Mydriatic (tropicamide and phenylephrine).
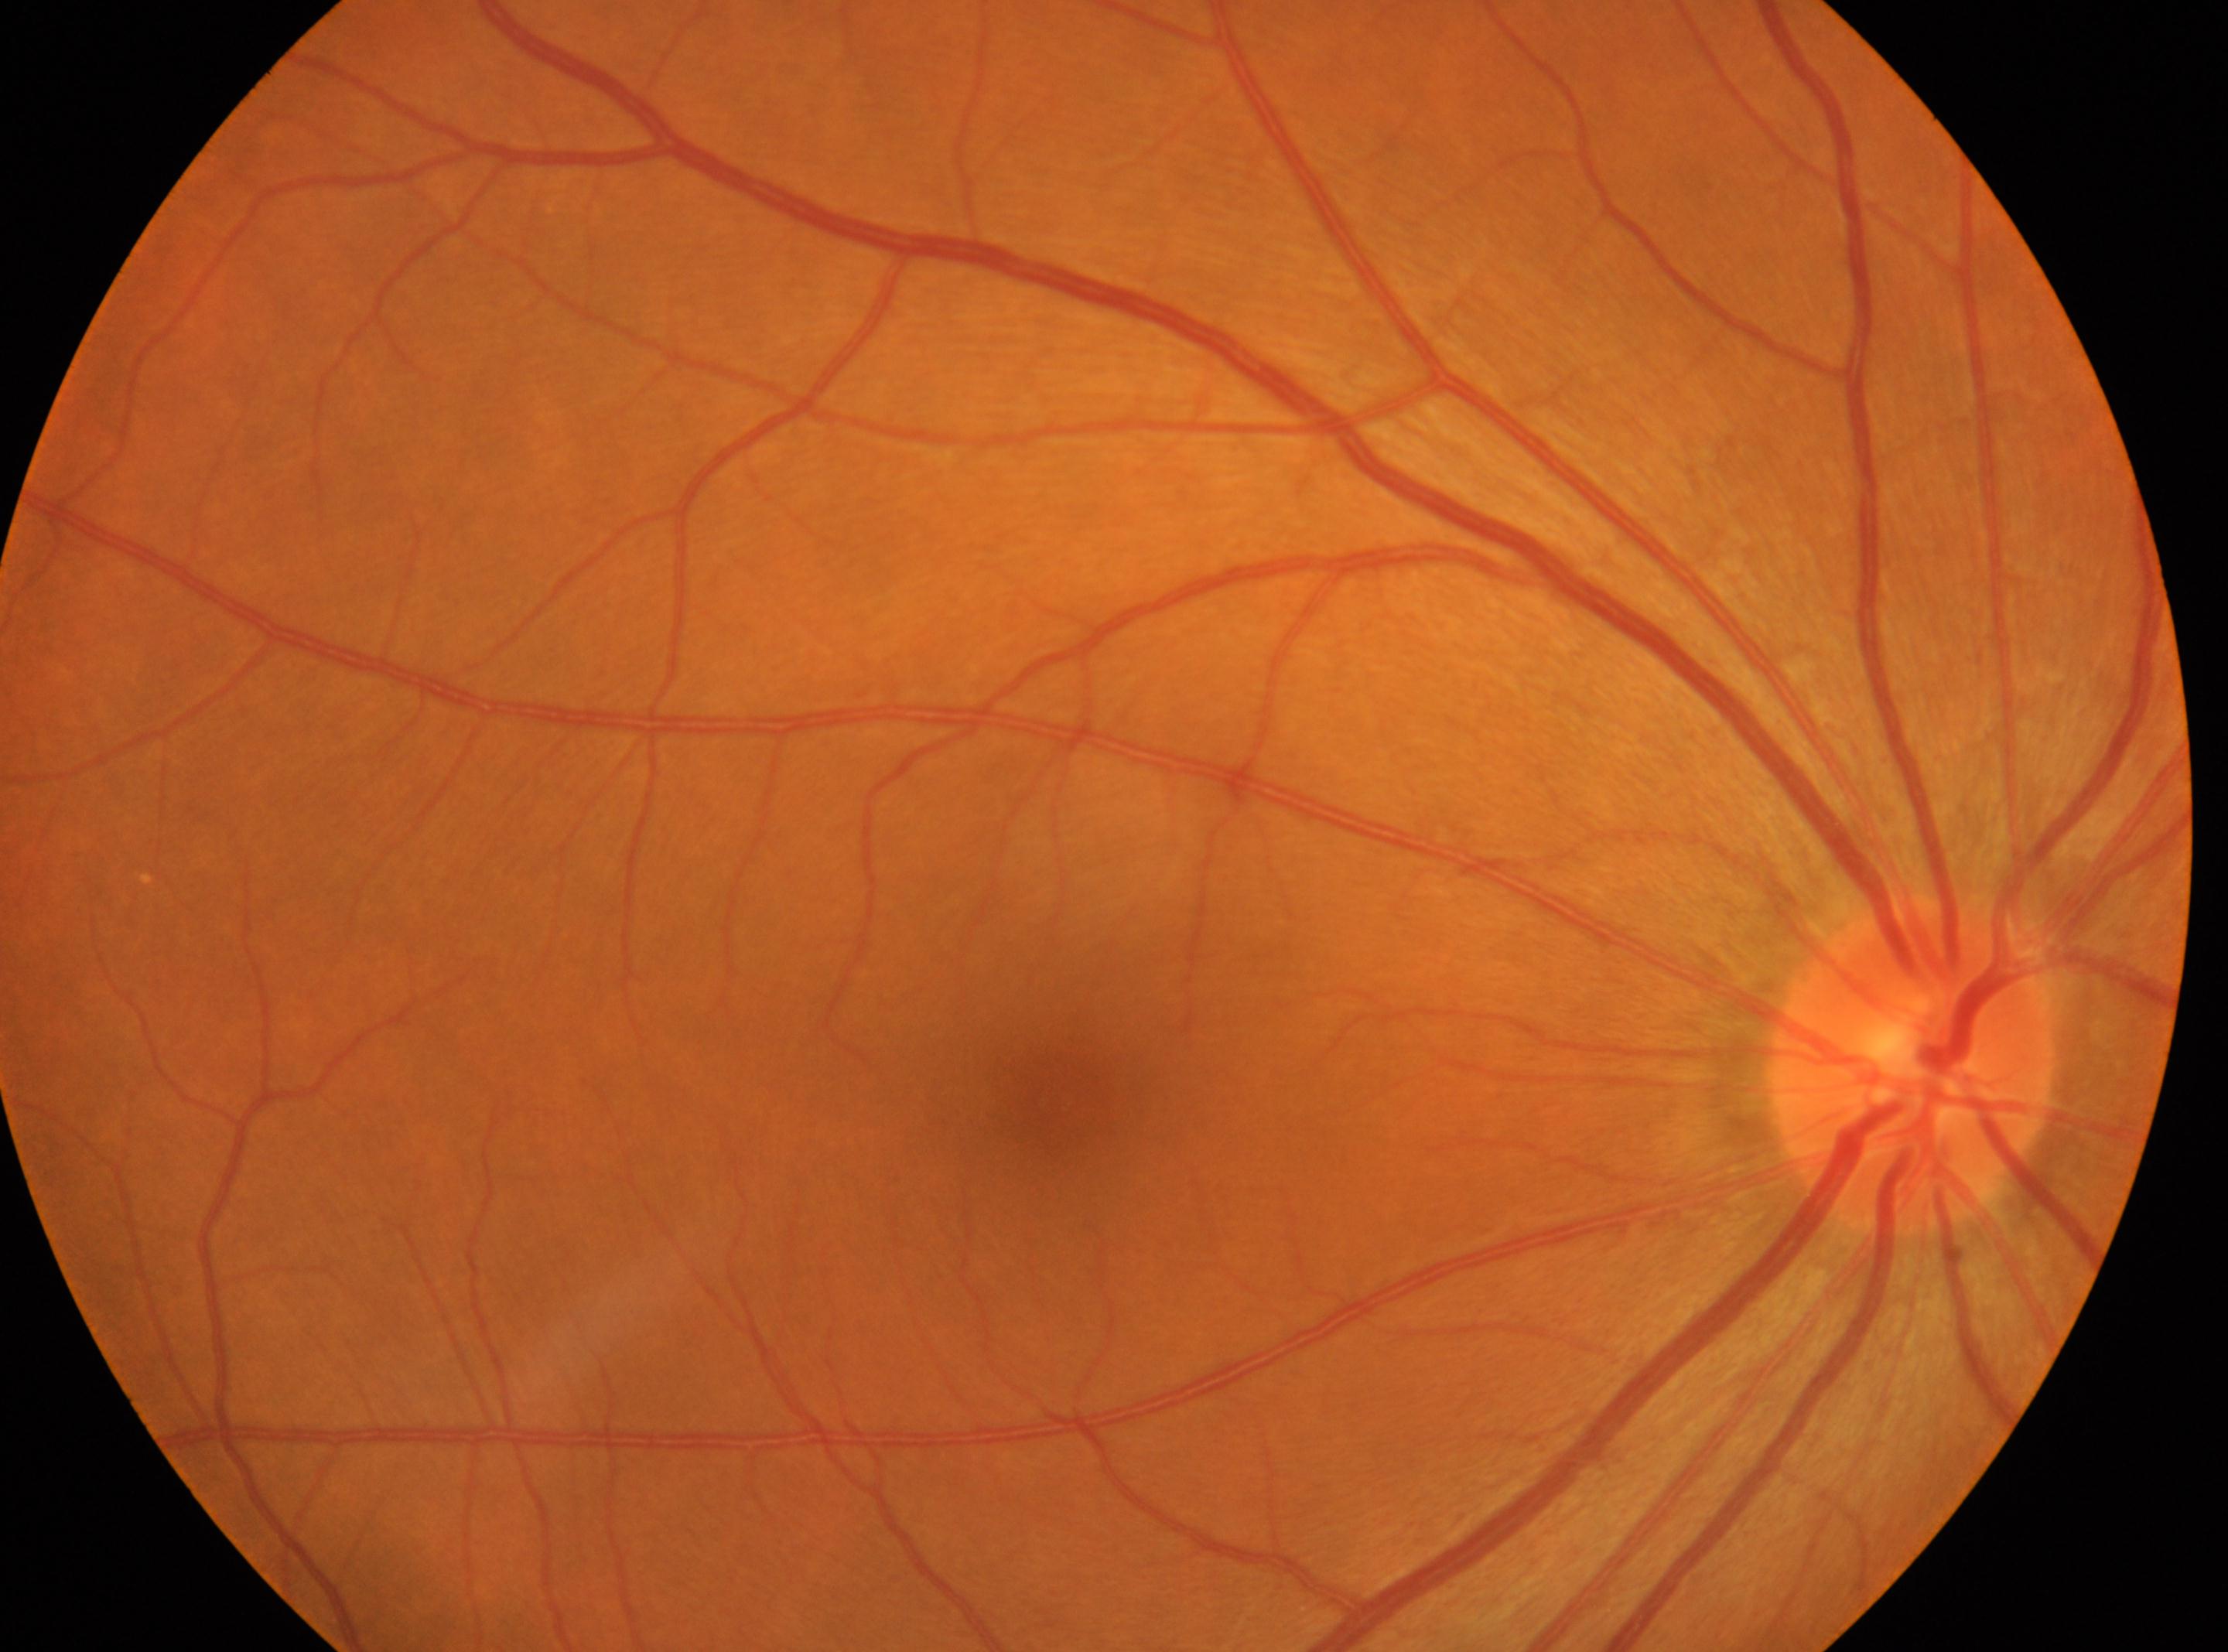 Q: Right or left eye?
A: the right eye
Q: Locate the optic disc.
A: (1911,1064)
Q: DR stage?
A: grade 0 — no visible signs of diabetic retinopathy
Q: Fovea center?
A: (1058,1097)